848 by 848 pixels · 45-degree field of view
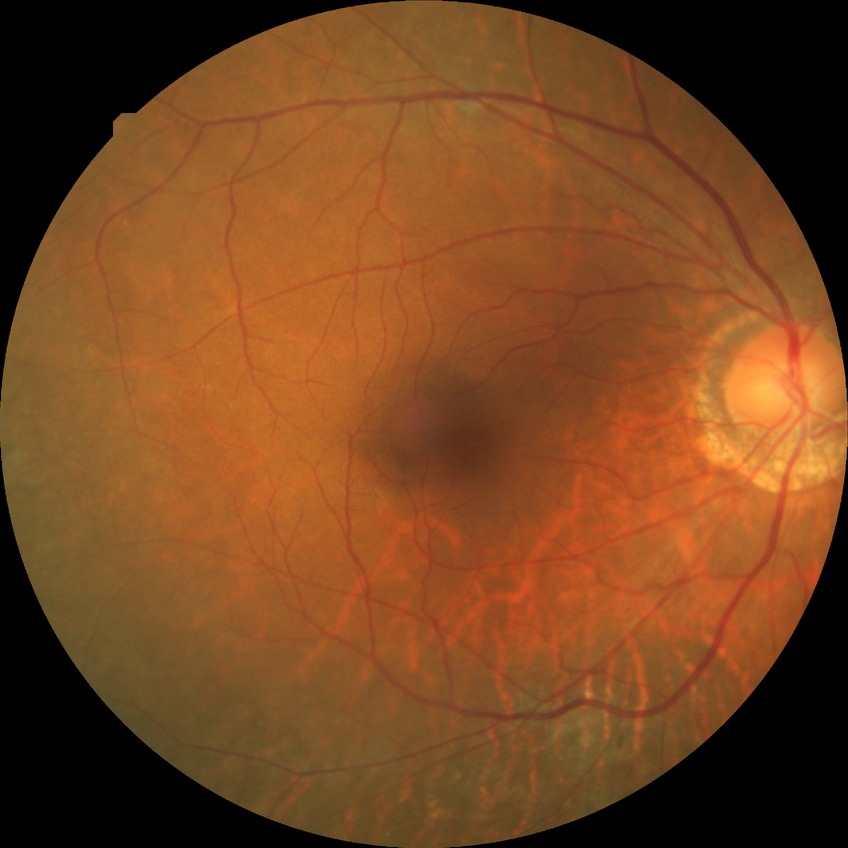
diabetic retinopathy (DR): no diabetic retinopathy (NDR).